Wide-field fundus photograph of an infant.
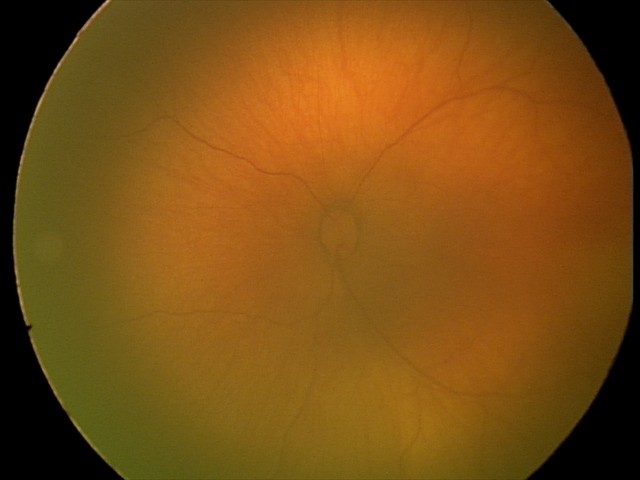 Impression = normal.